FOV: 45 degrees. Graded on the modified Davis scale. Image size 848x848:
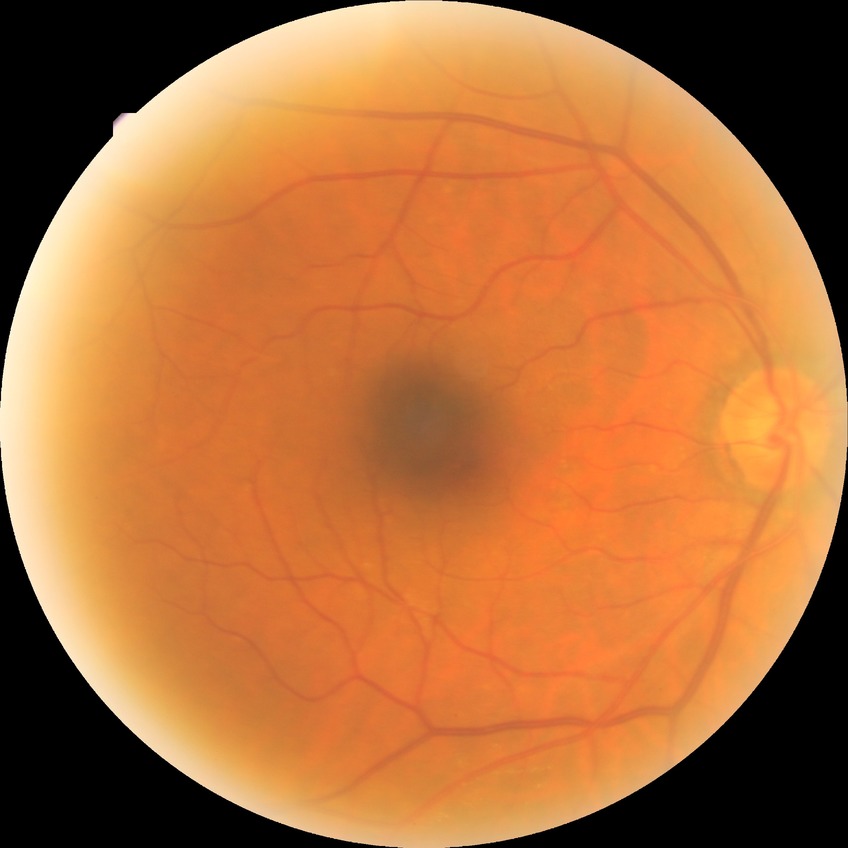 Diabetic retinopathy grade: no diabetic retinopathy.